Color fundus photograph
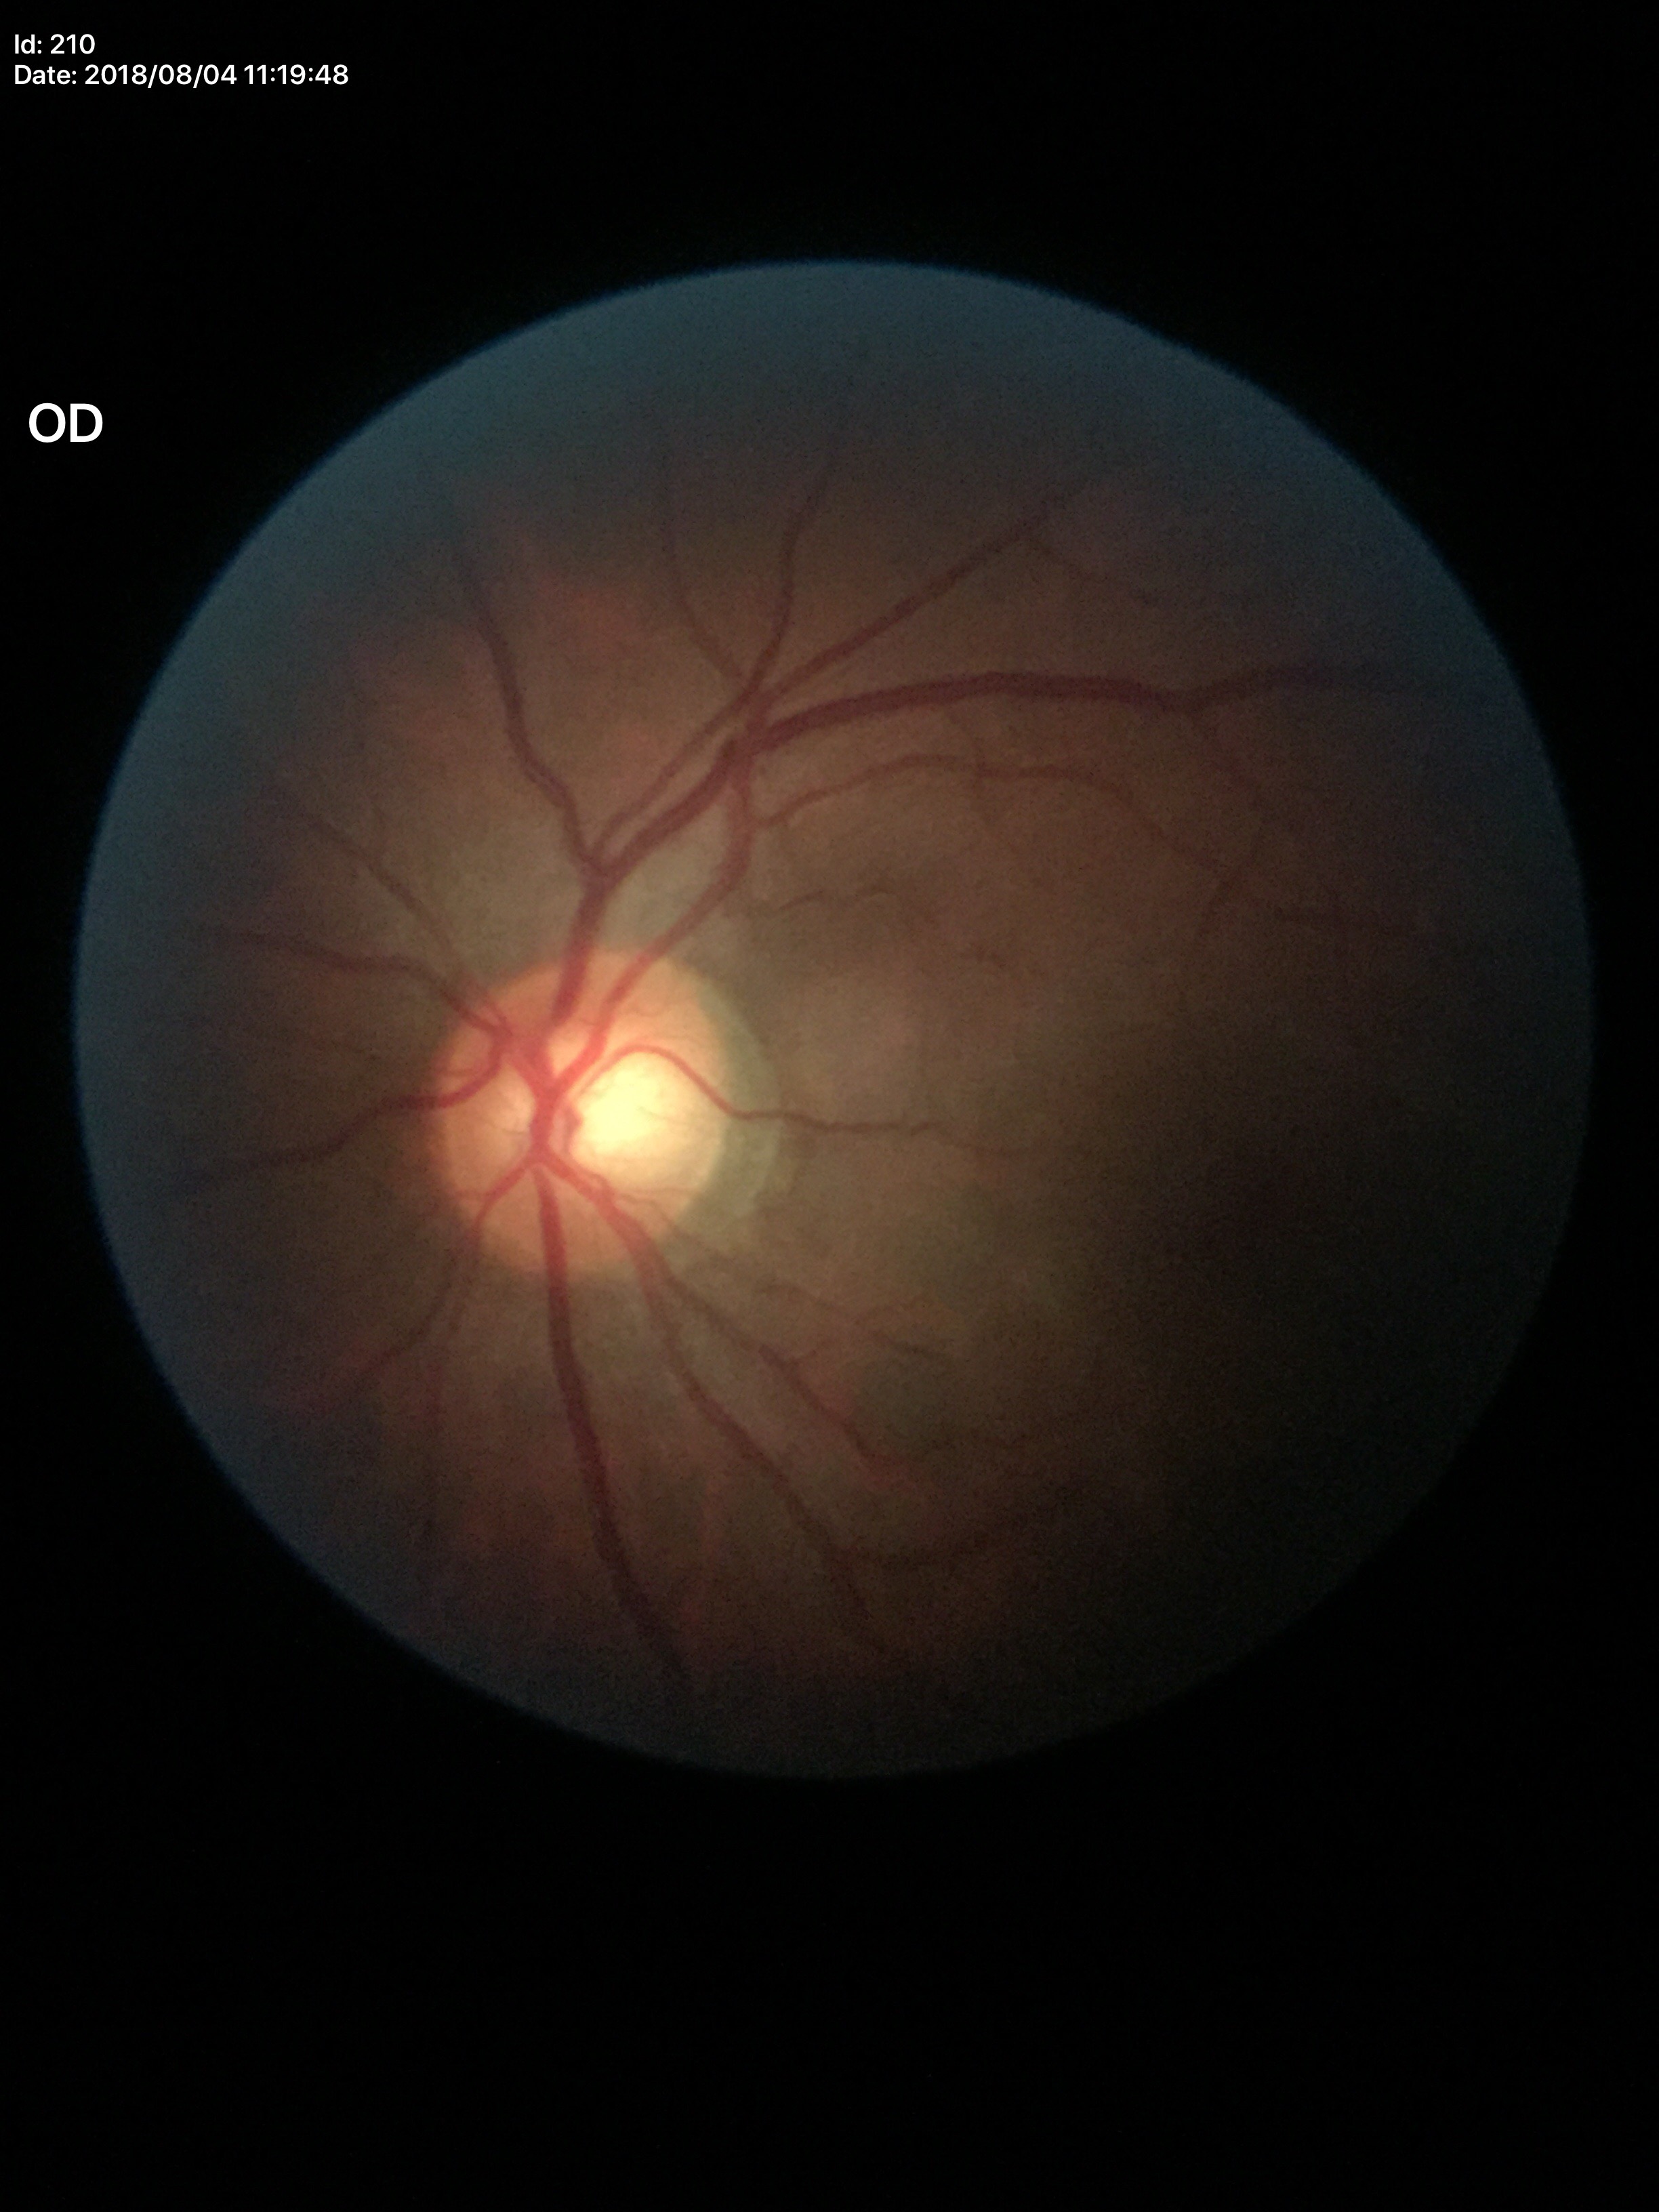 Optic disc analysis:
- Glaucoma decision — suspect
- vertical CDR — 0.60
- horizontal cup-disc ratio — 0.70